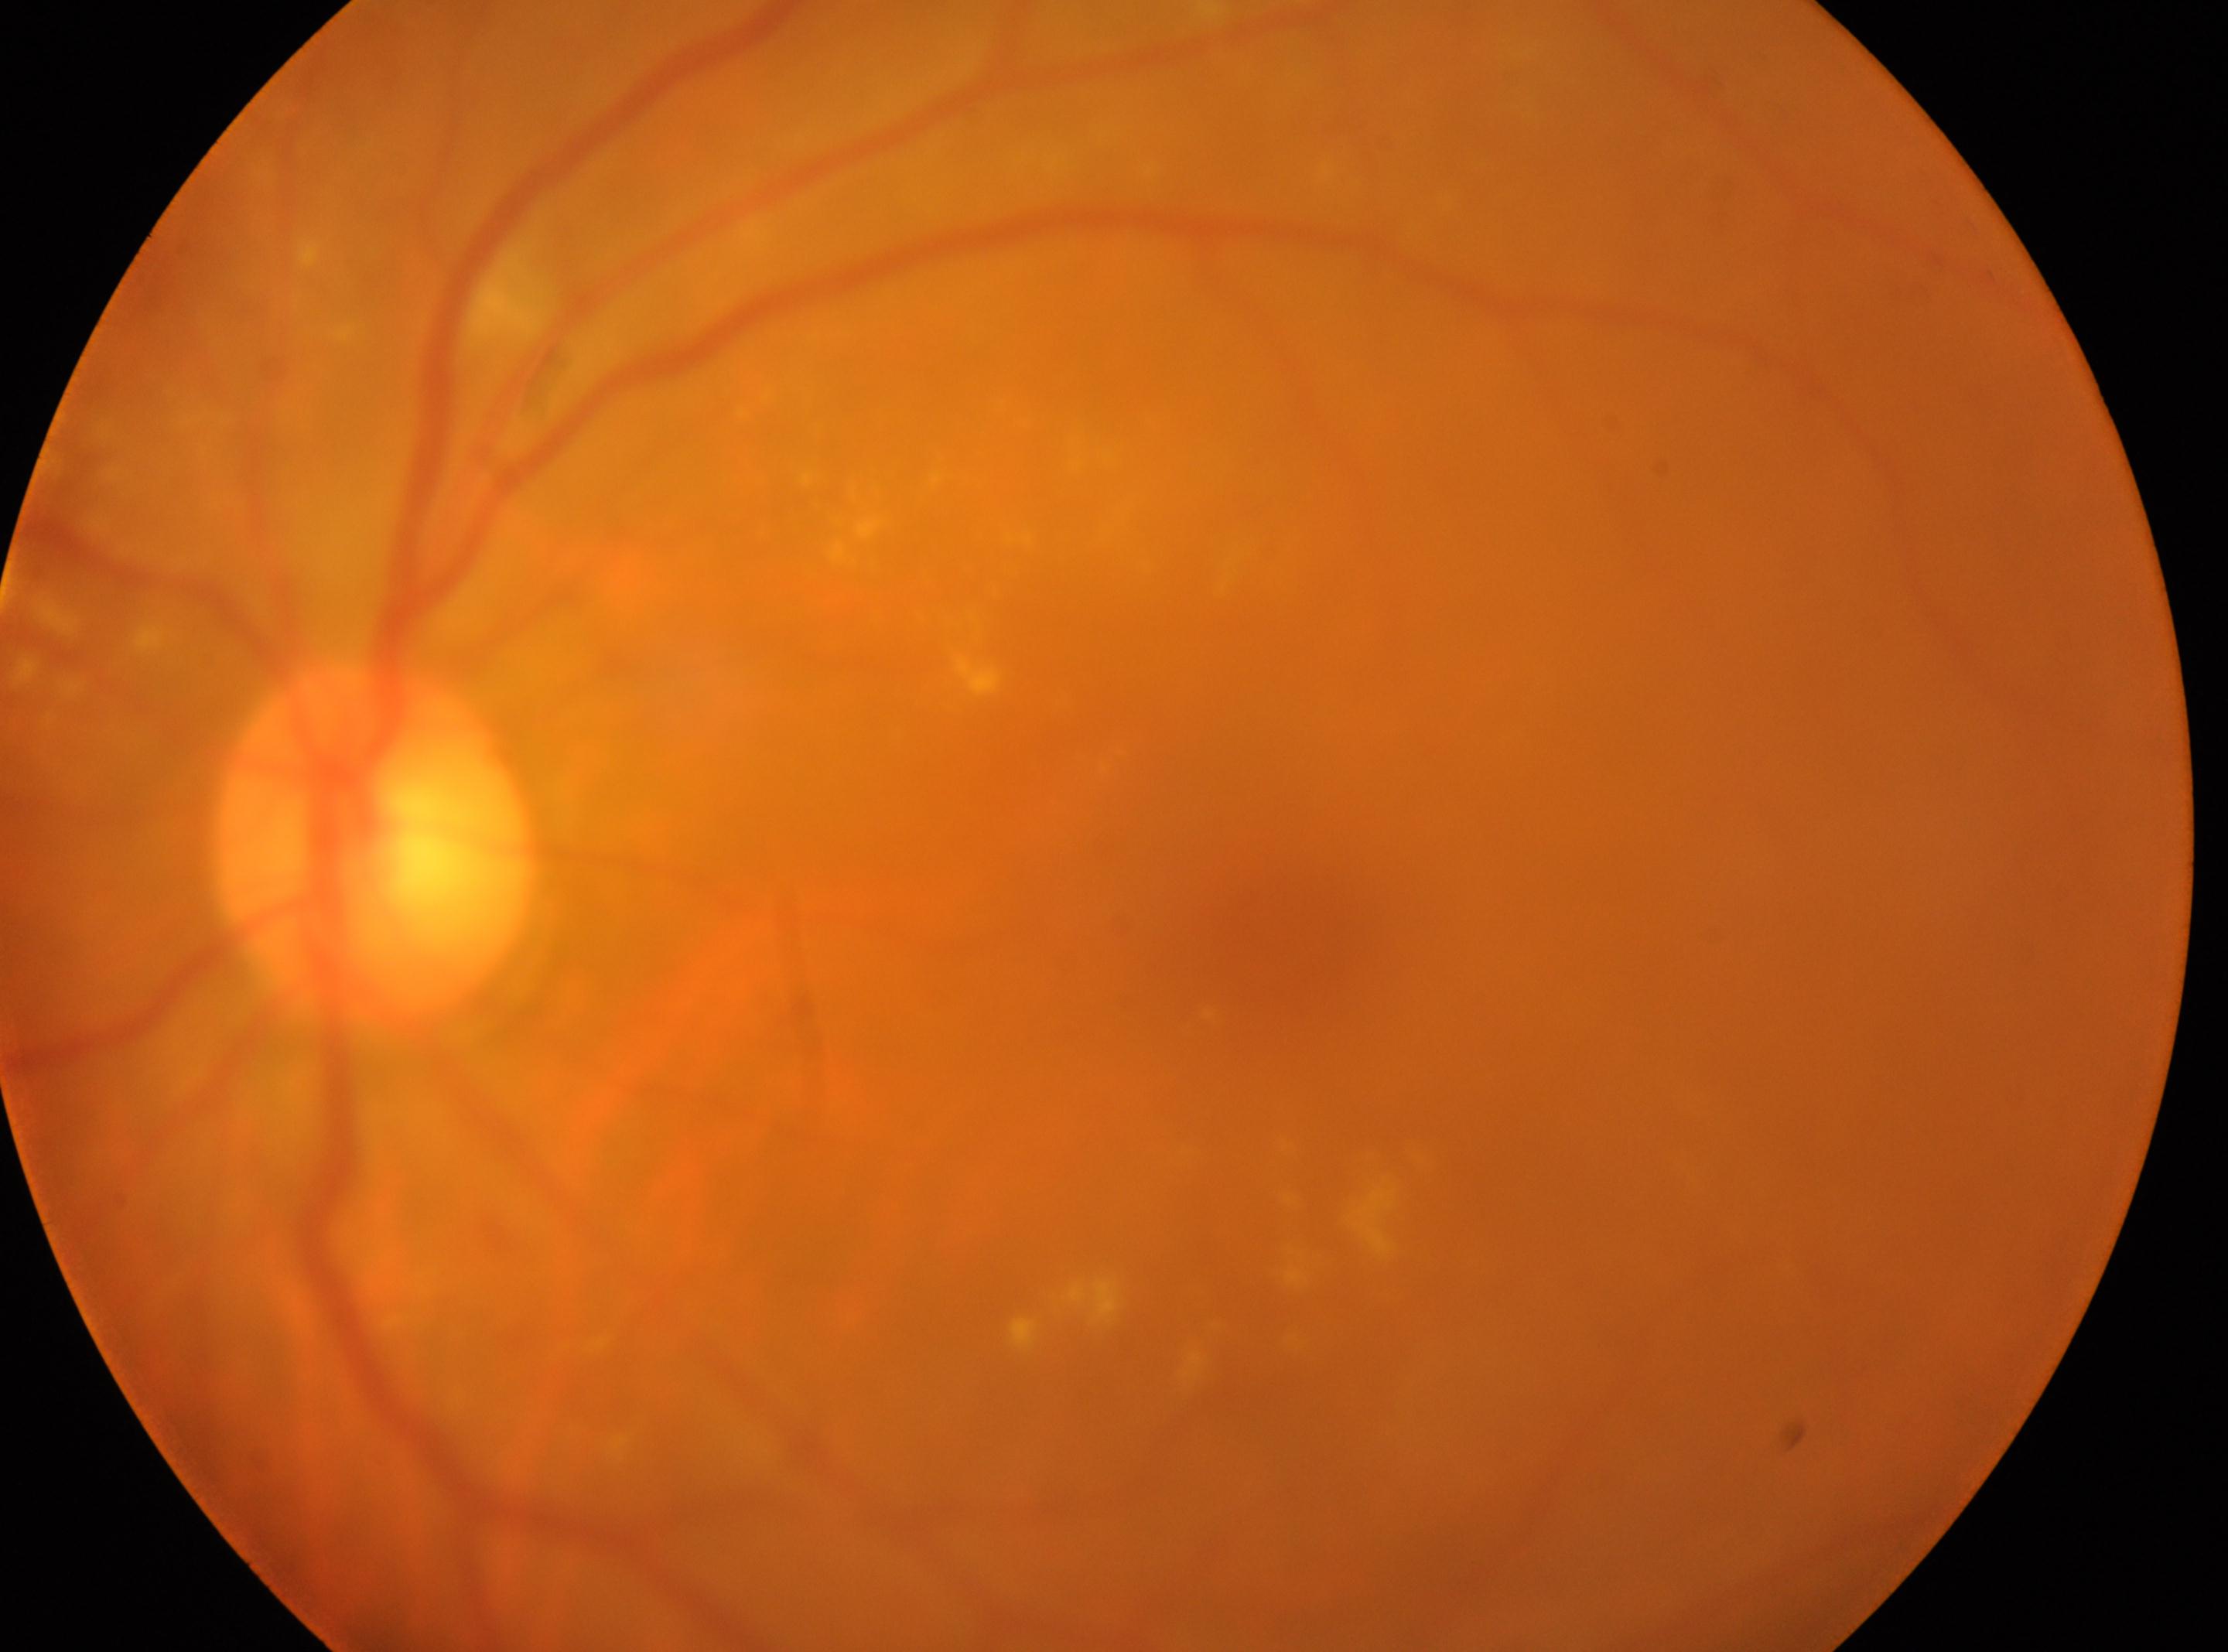
Foveal center located at 1290, 961.
The image shows the left eye.
DR severity: moderate NPDR (grade 2).
Optic disc located at 371, 845.